45-degree field of view; CFP; 2048 by 1536 pixels:
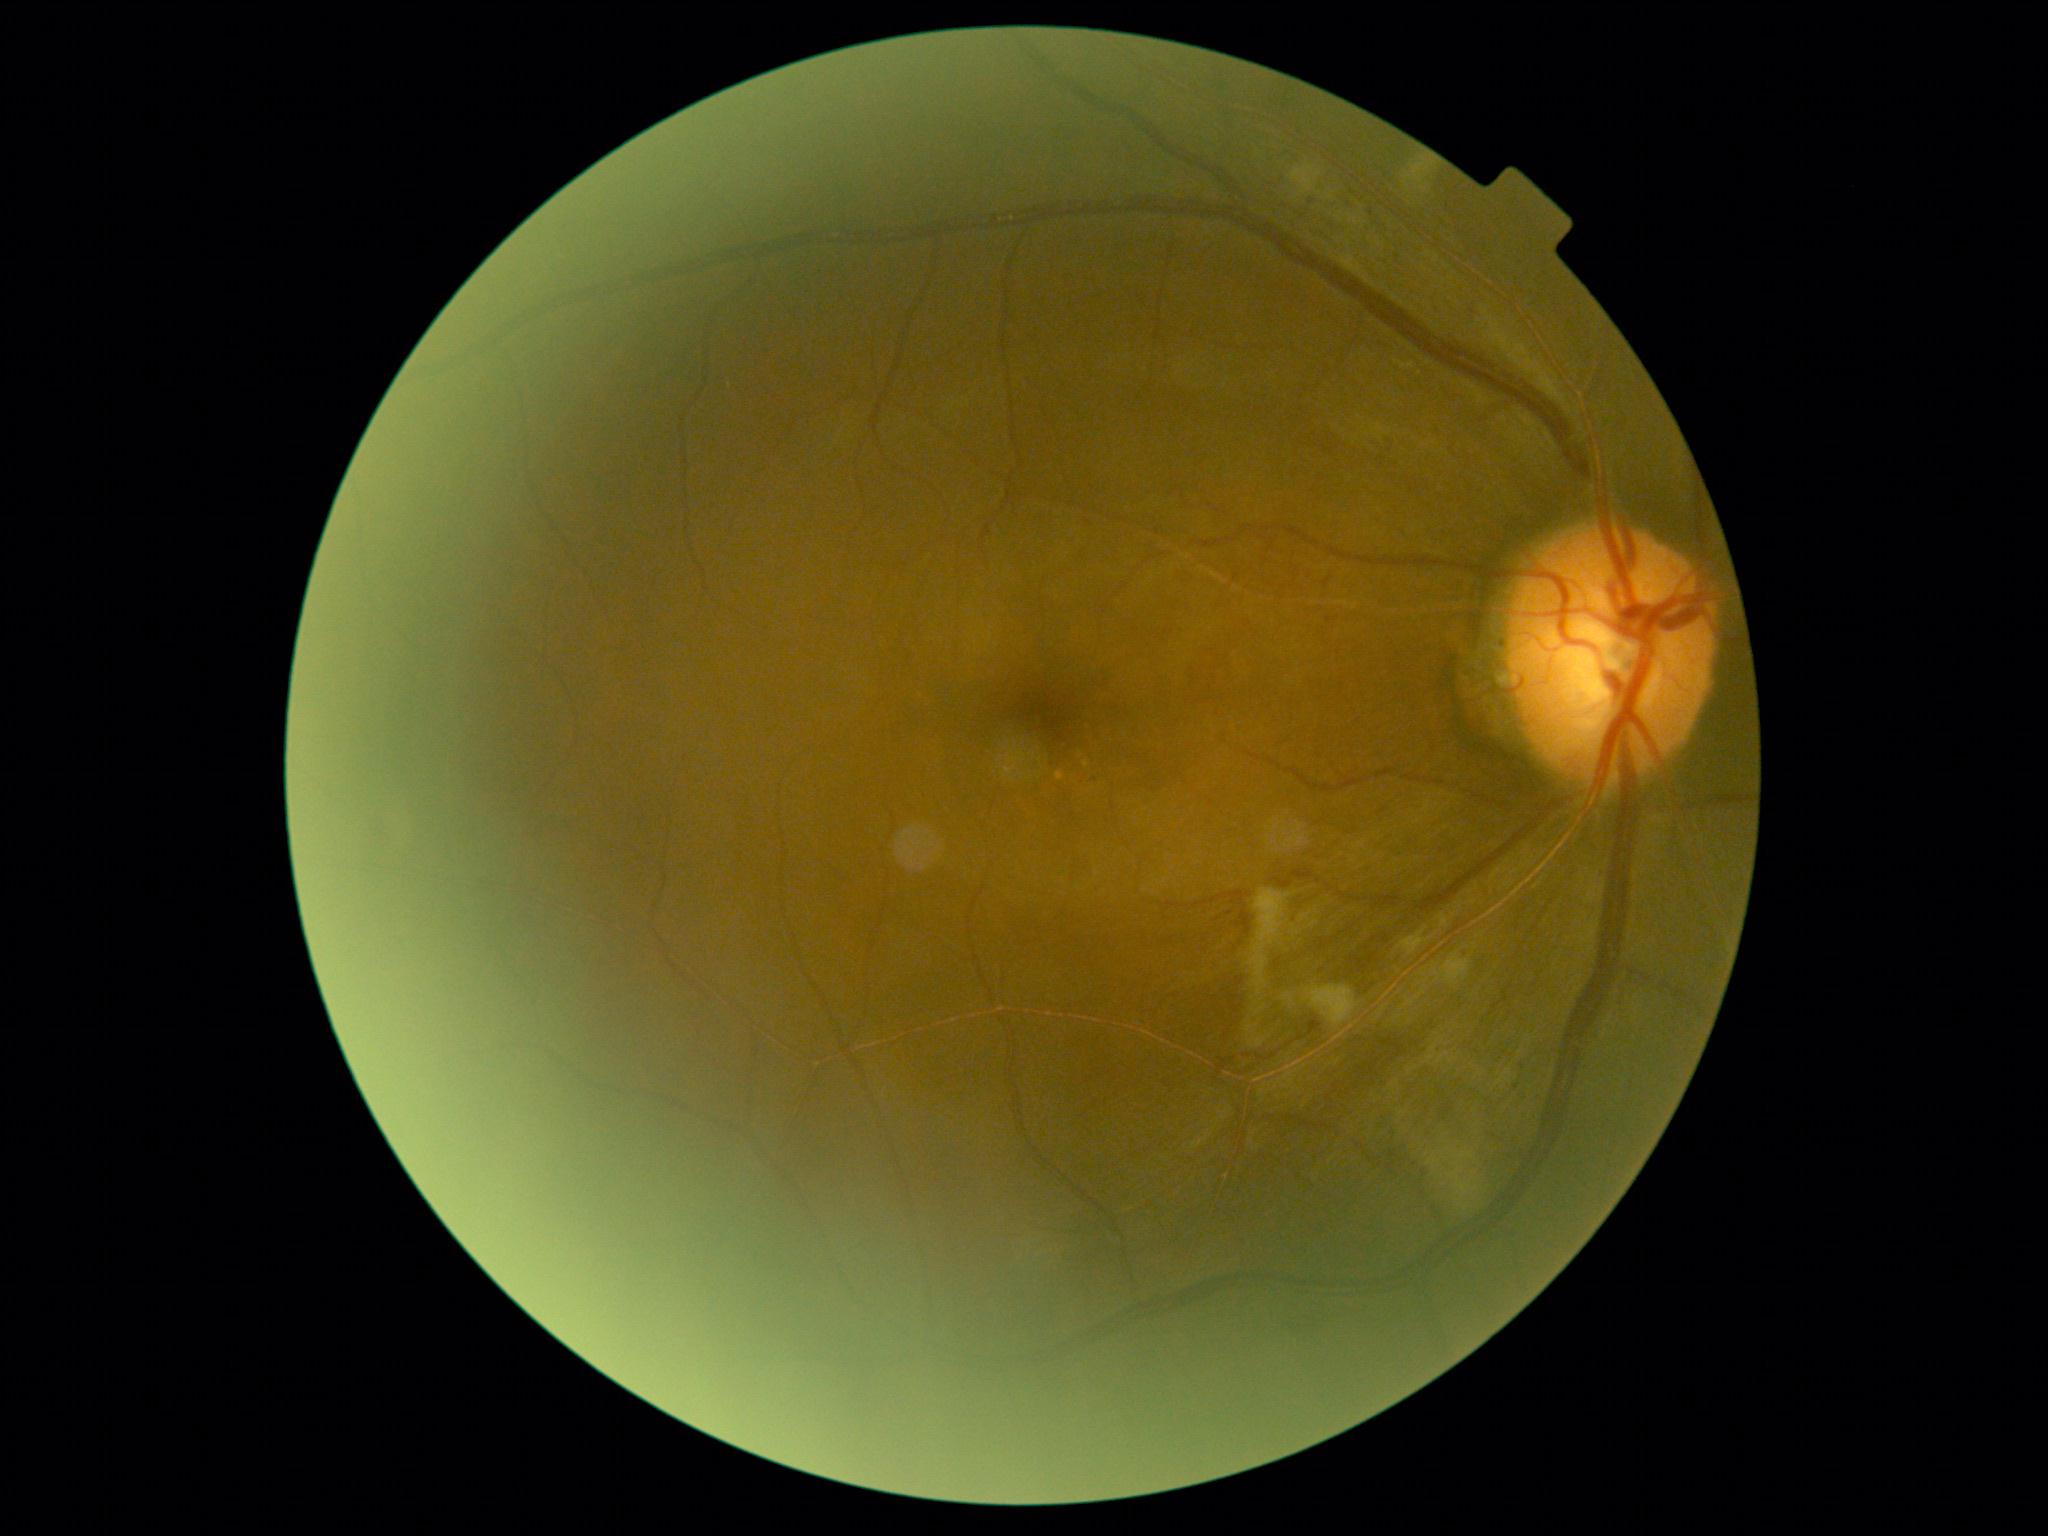
DR severity: grade 2.